Color fundus image, 2352x1568, FOV: 45 degrees:
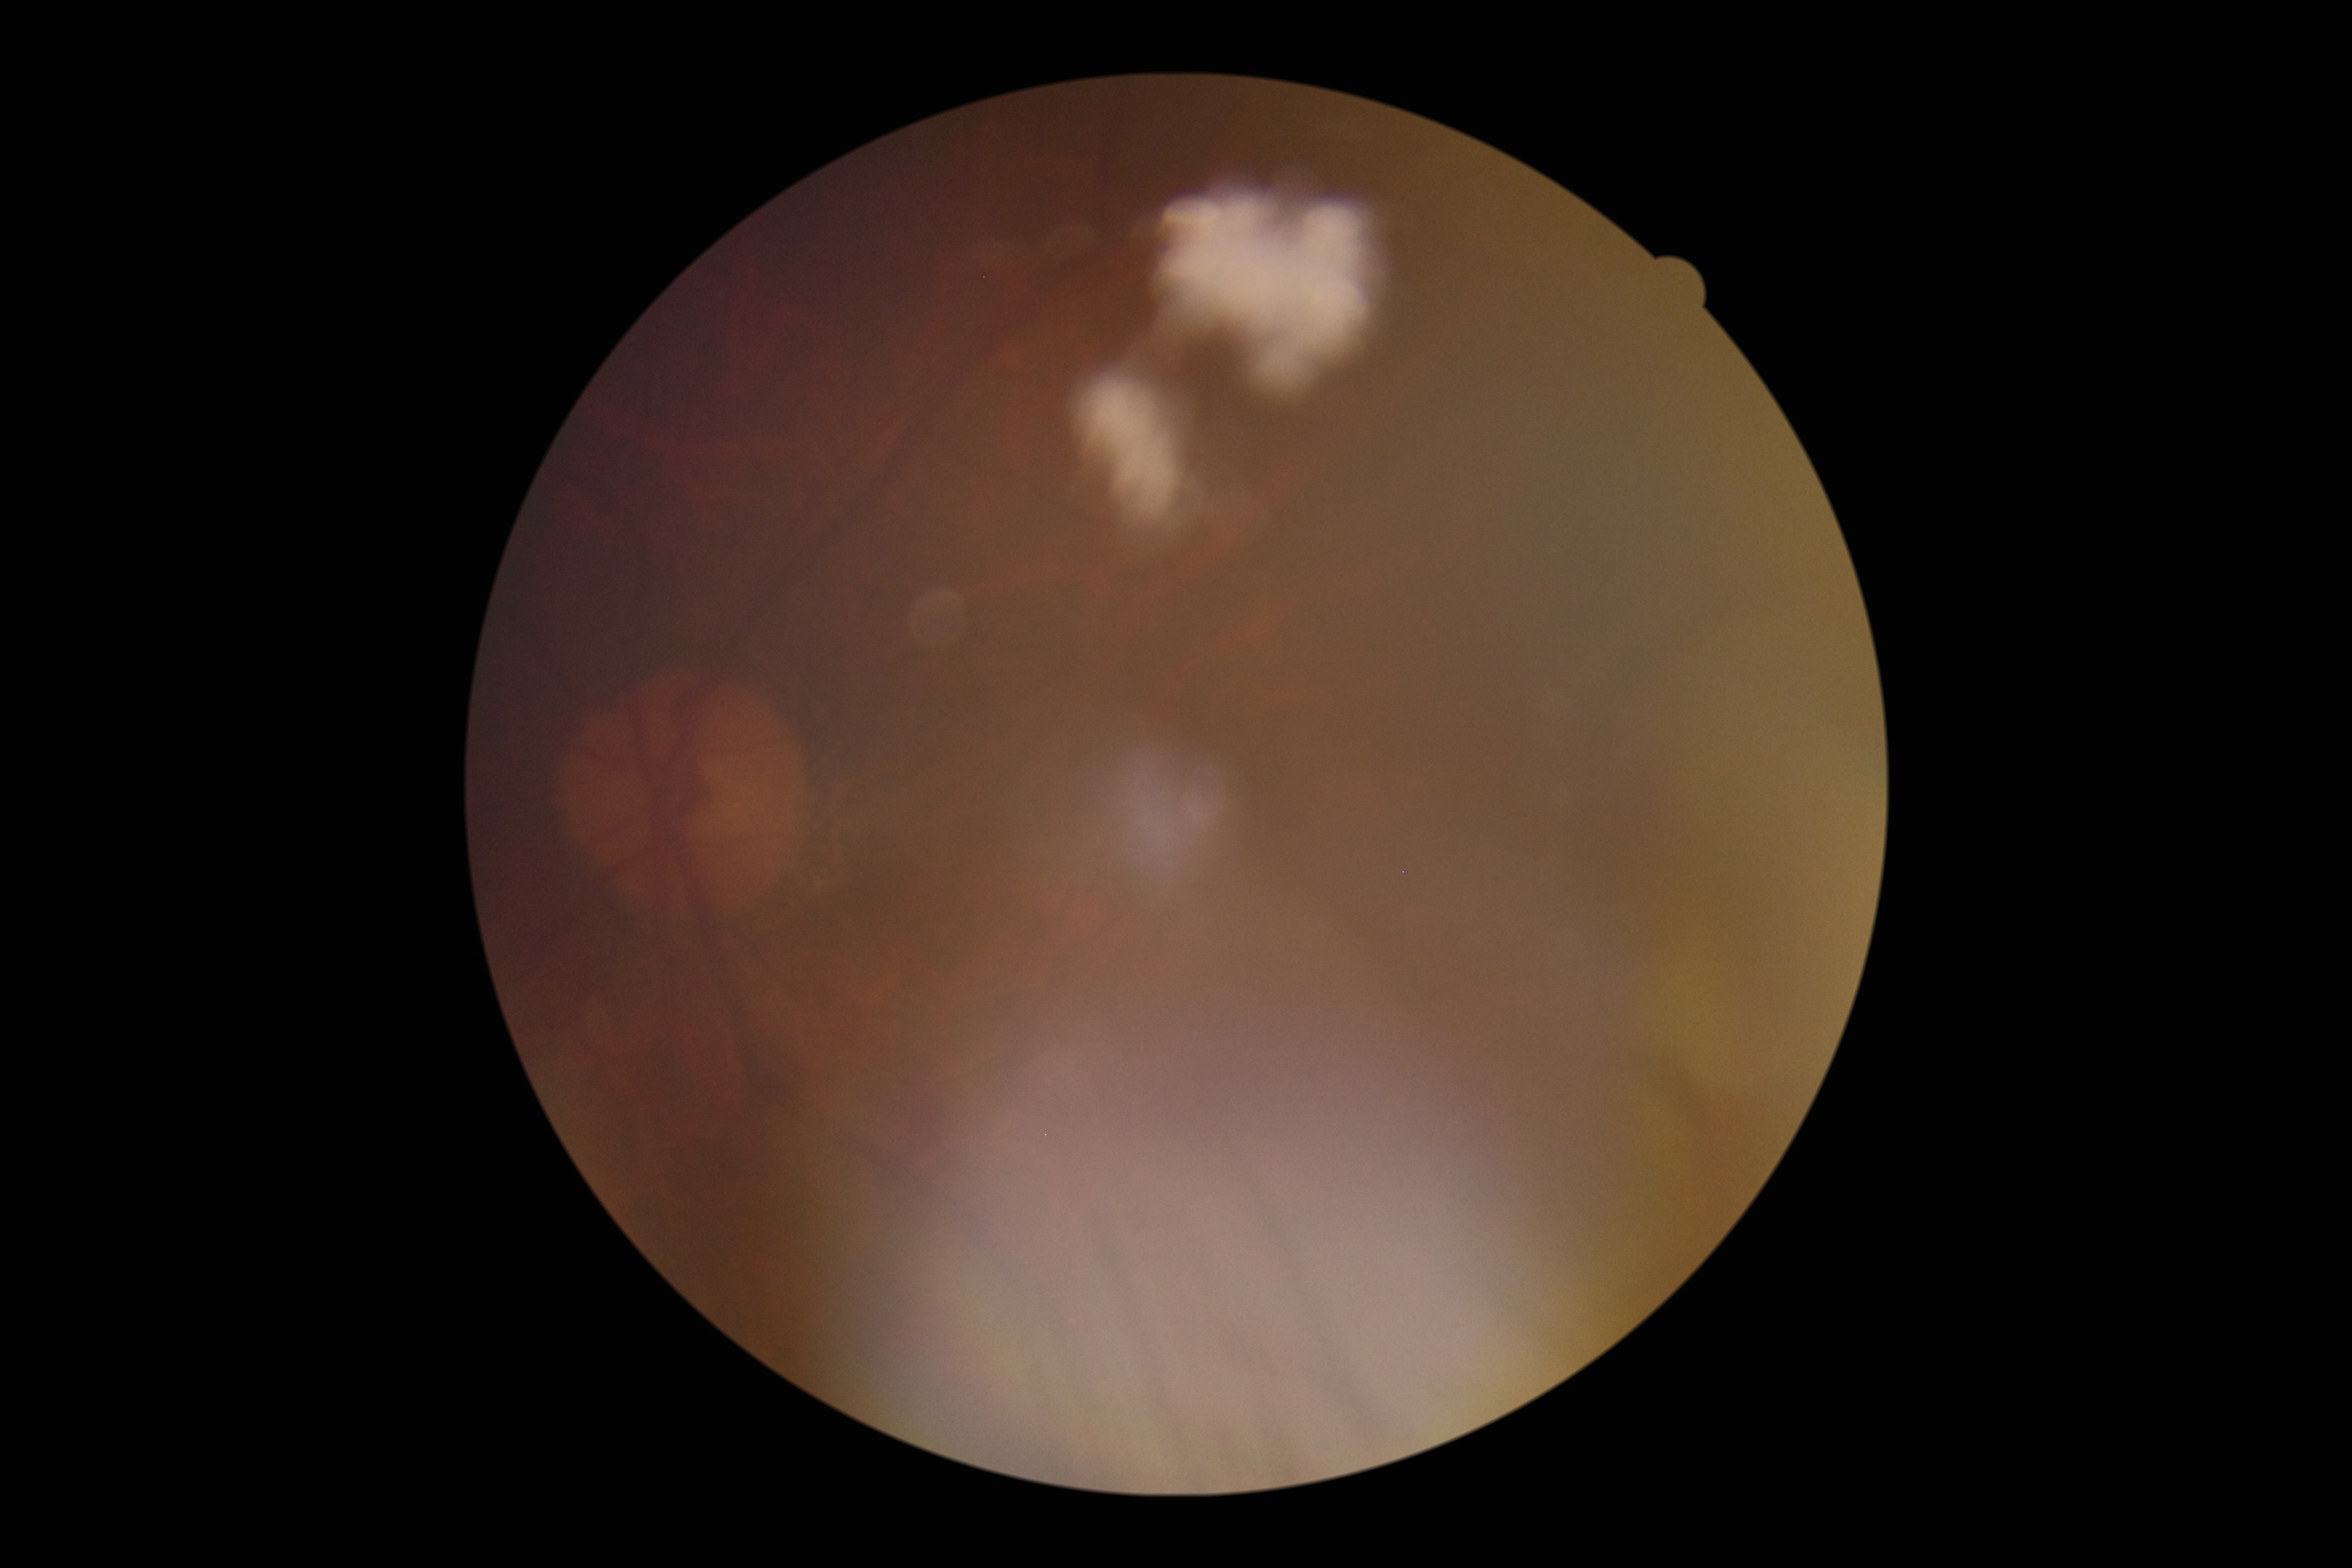 * image quality — below grading threshold
* DR grade — ungradable due to poor image quality